Acquired on the Phoenix ICON; 1240 by 1240 pixels; infant wide-field fundus photograph
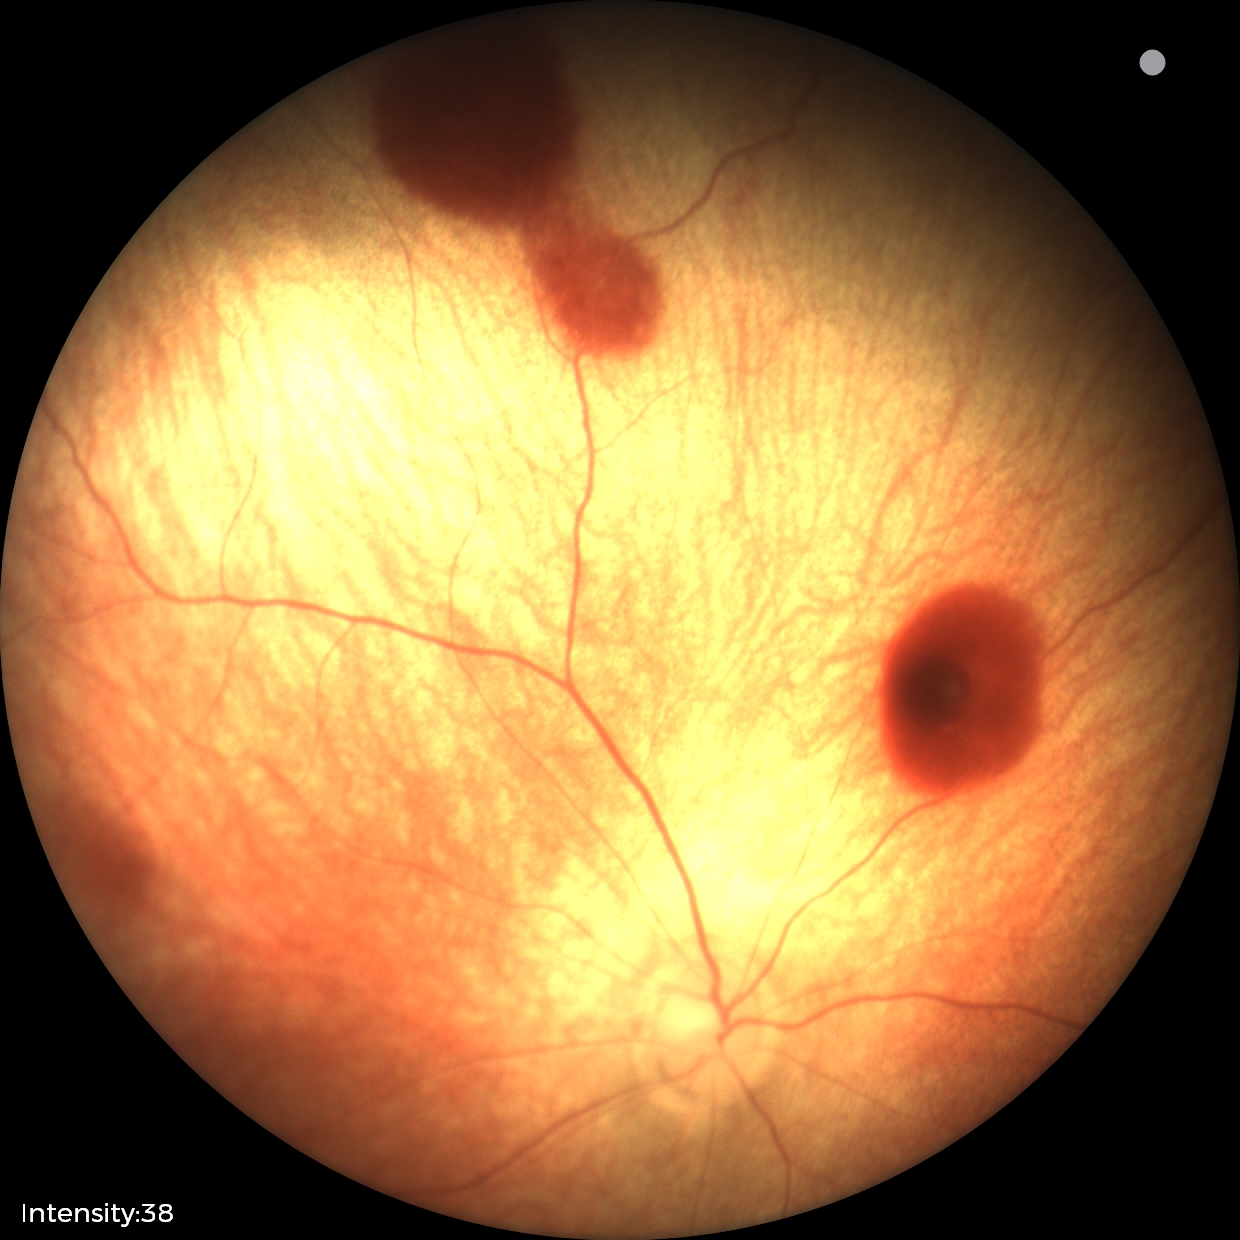 From an examination with diagnosis of retinal hemorrhages.